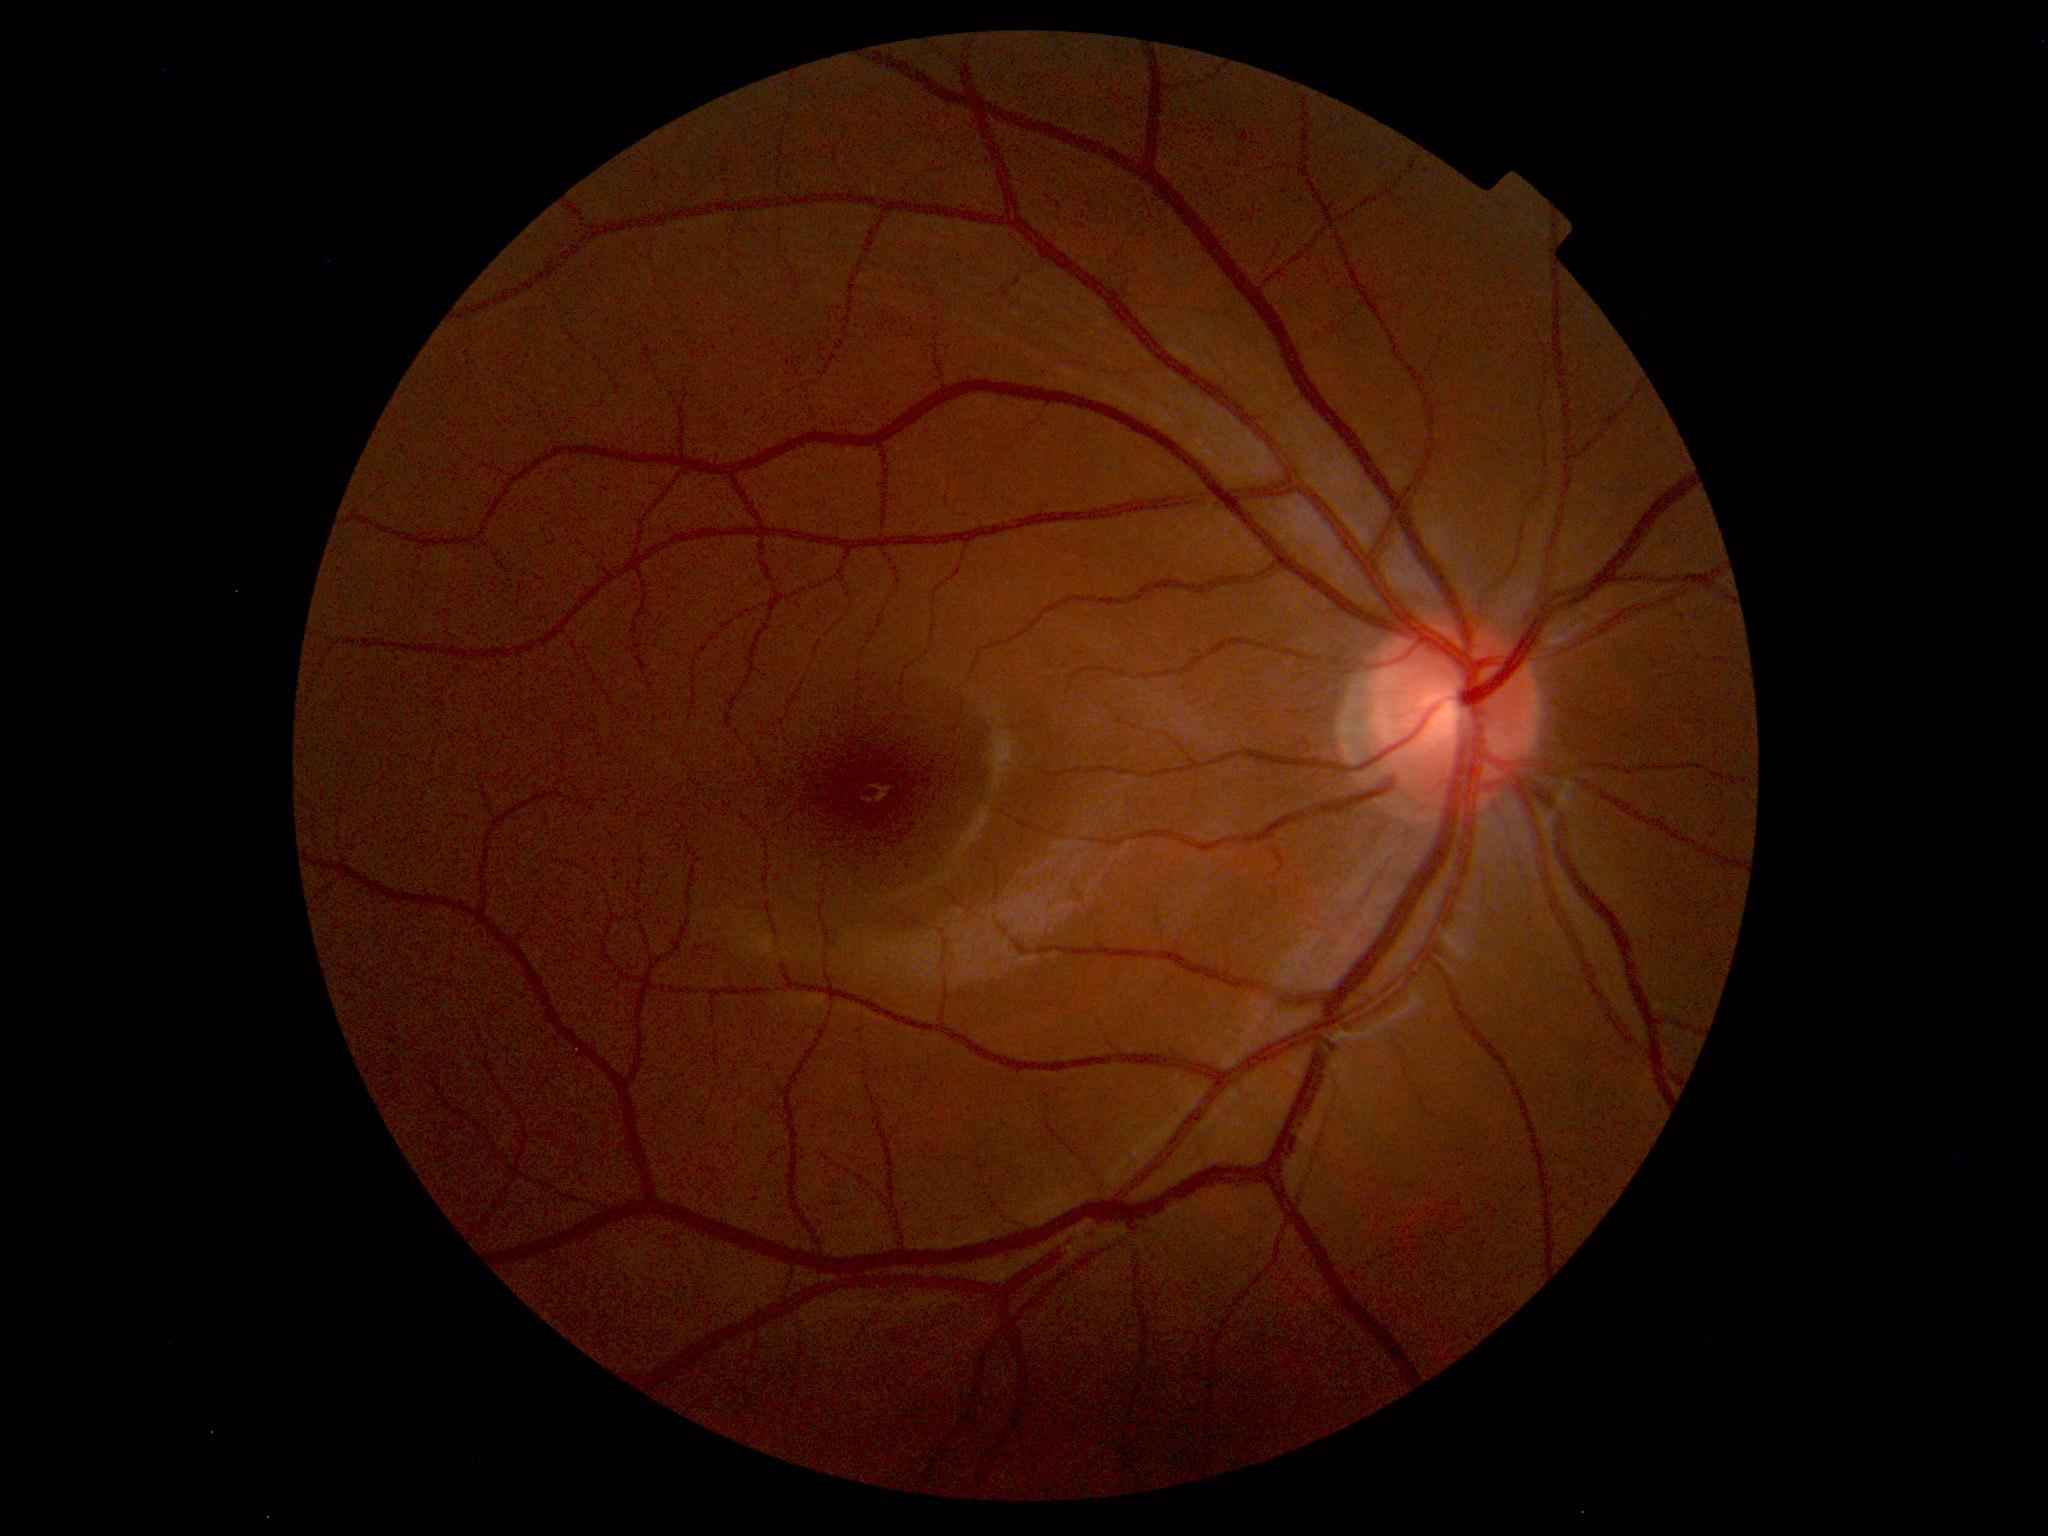

Findings: none. Normal fundus.